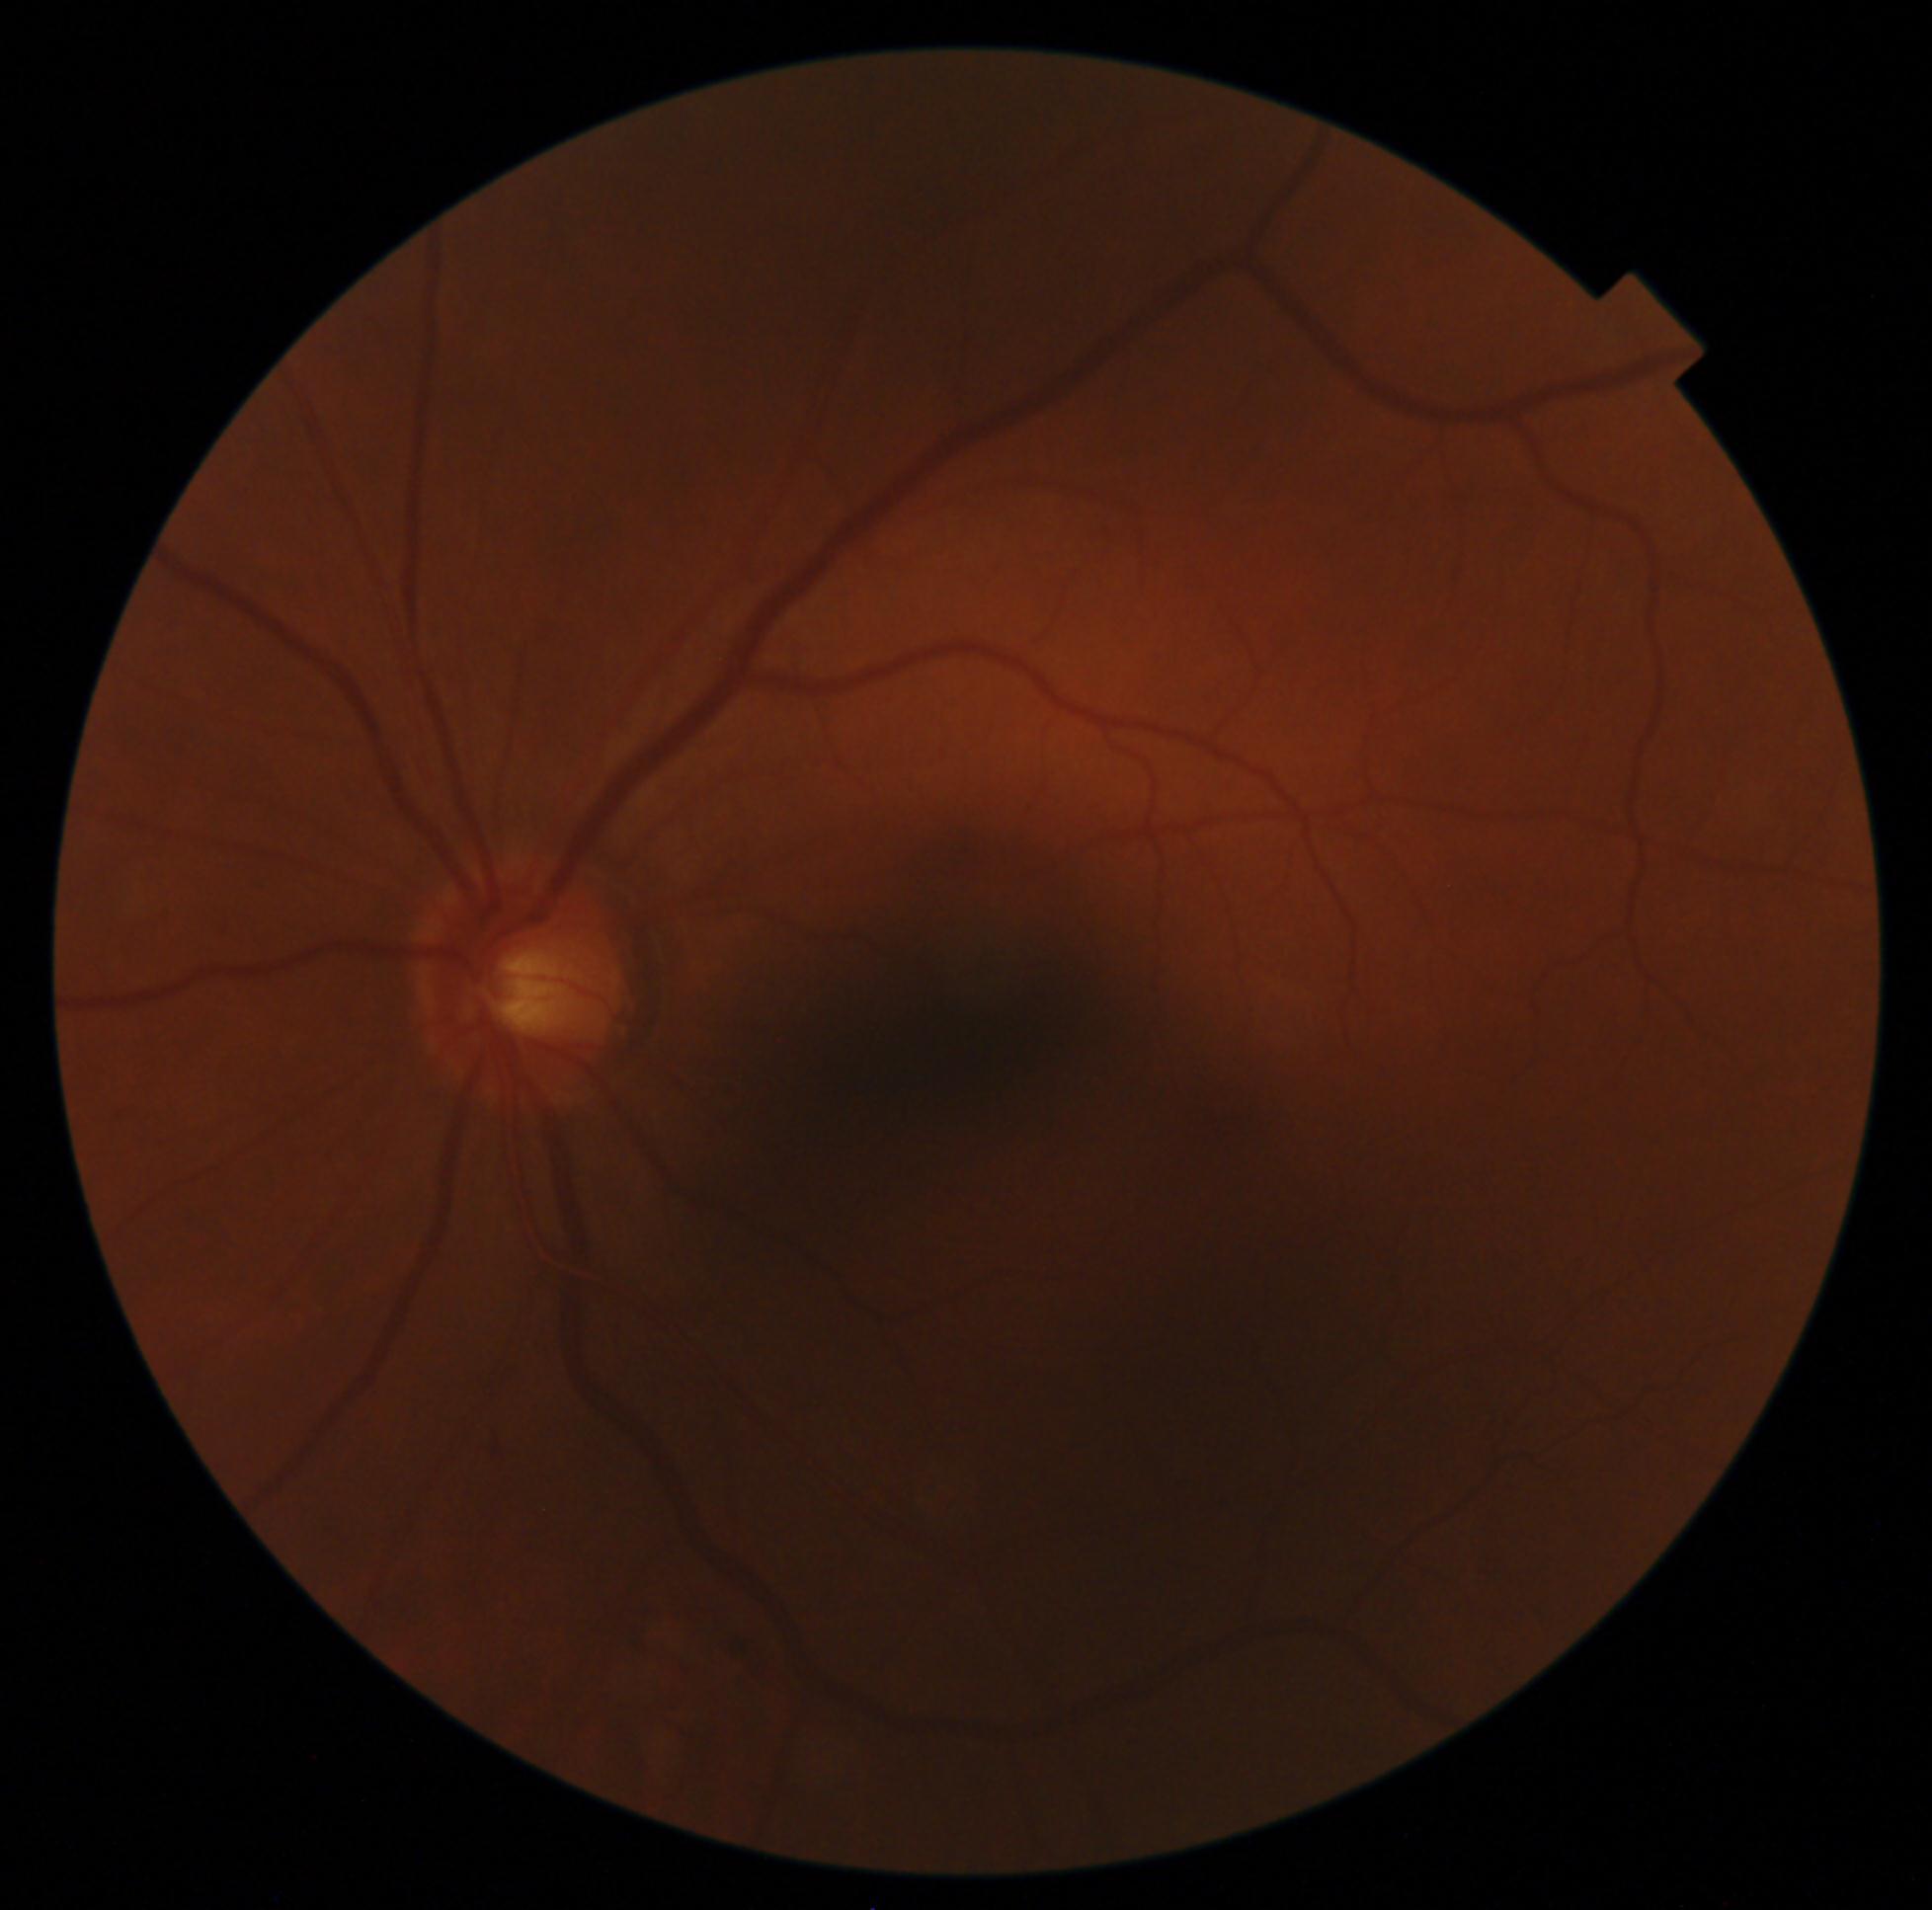
{
  "dr_grade": "moderate NPDR (grade 2) — more than just microaneurysms but less than severe NPDR"
}